1240x1240; pediatric retinal photograph (wide-field): 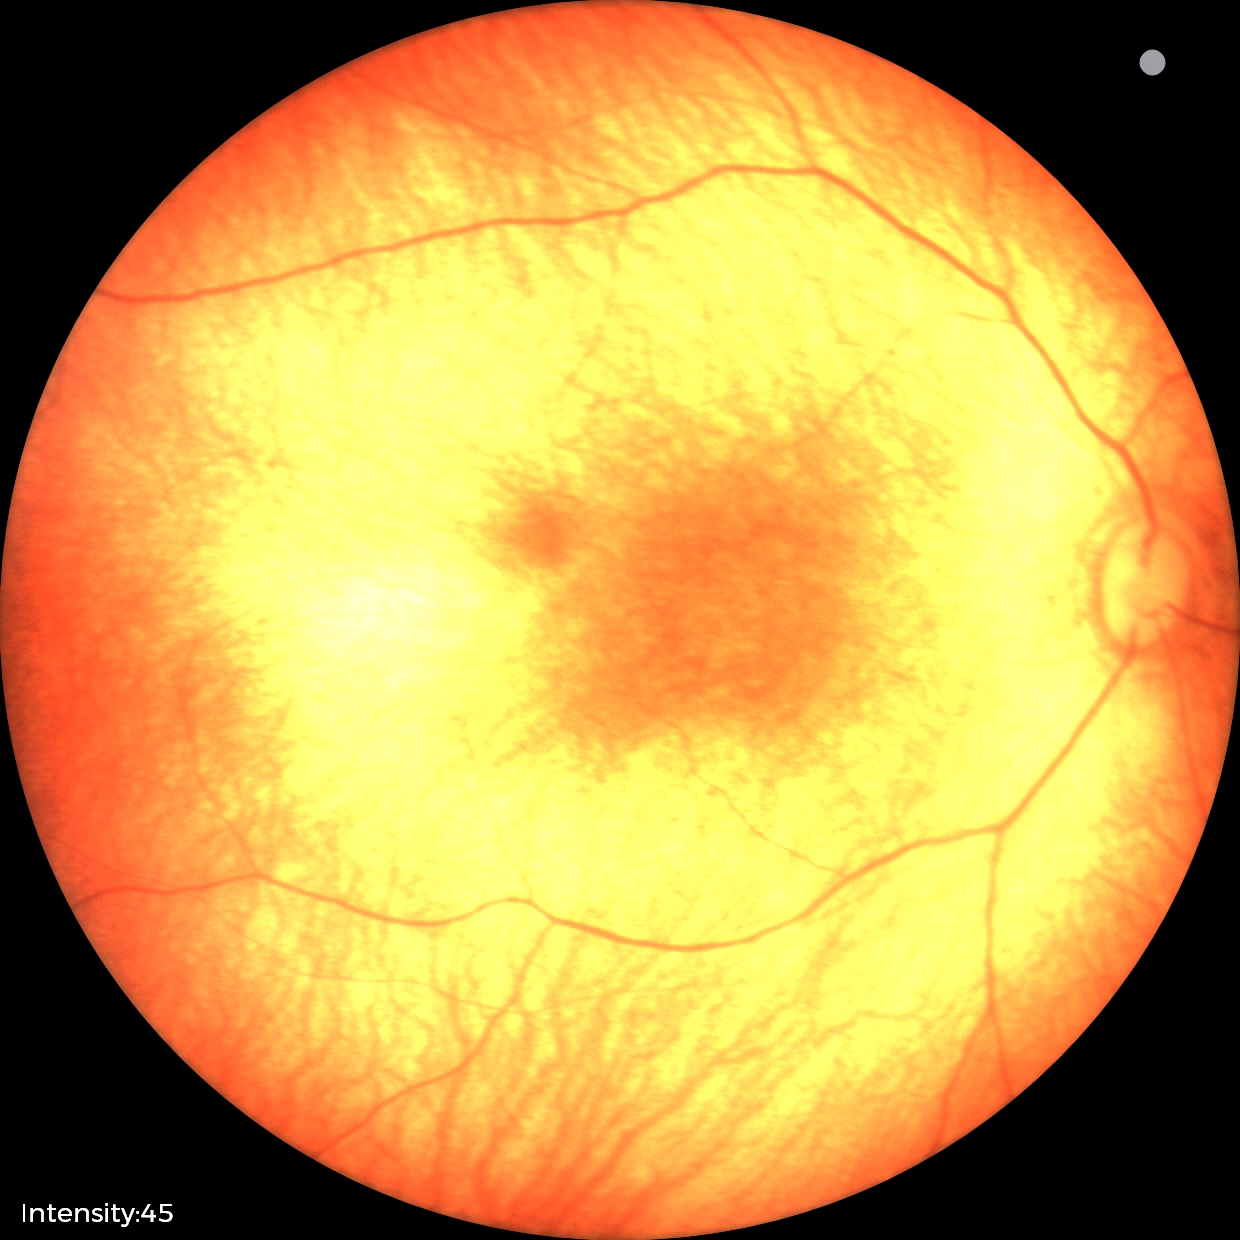

Screening diagnosis: physiological retinal finding.